Posterior pole color fundus photograph
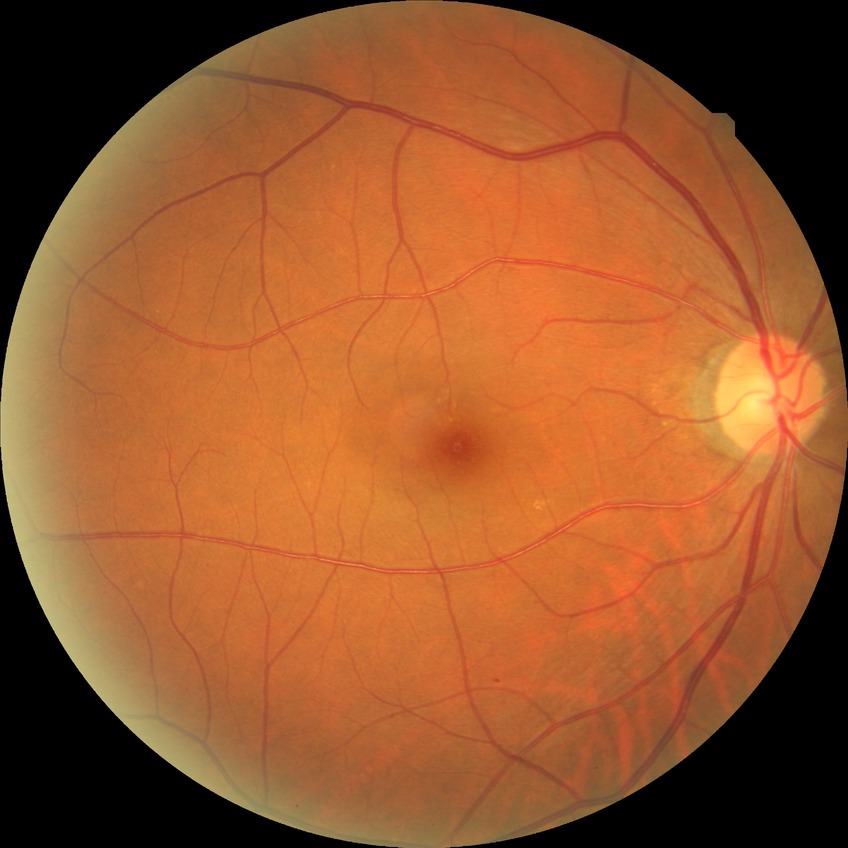 Retinopathy grade is no diabetic retinopathy.